Diabetic retinopathy graded by the modified Davis classification, 45° FOV, 848x848:
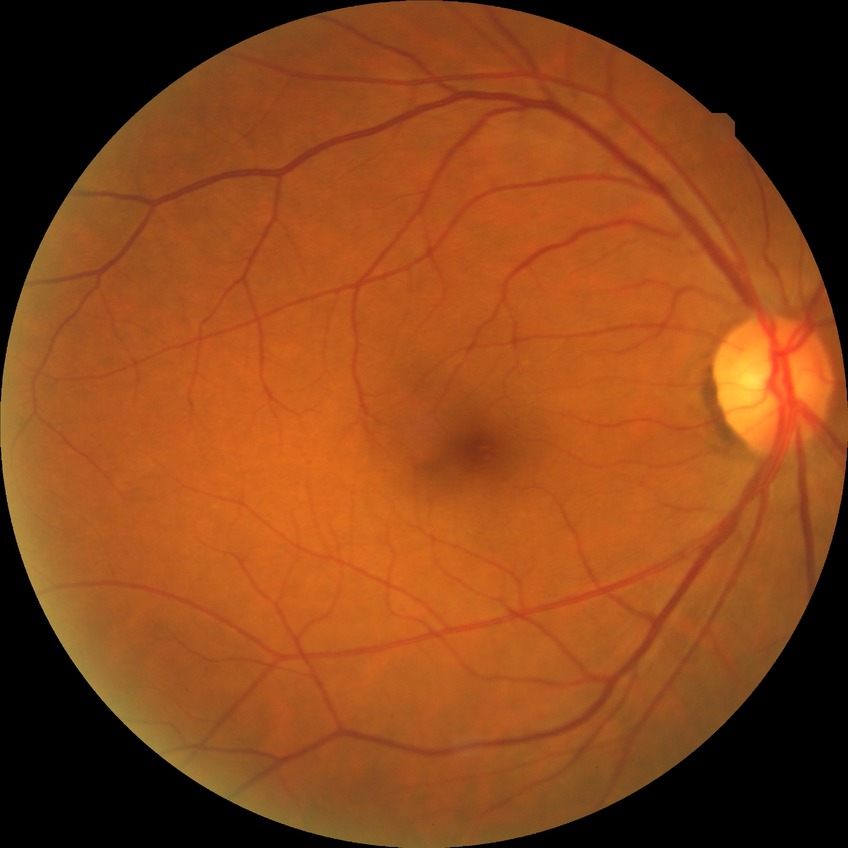 Diabetic retinopathy (DR): no diabetic retinopathy (NDR).